Acquired with a Topcon TRC-50DX · central posterior field: 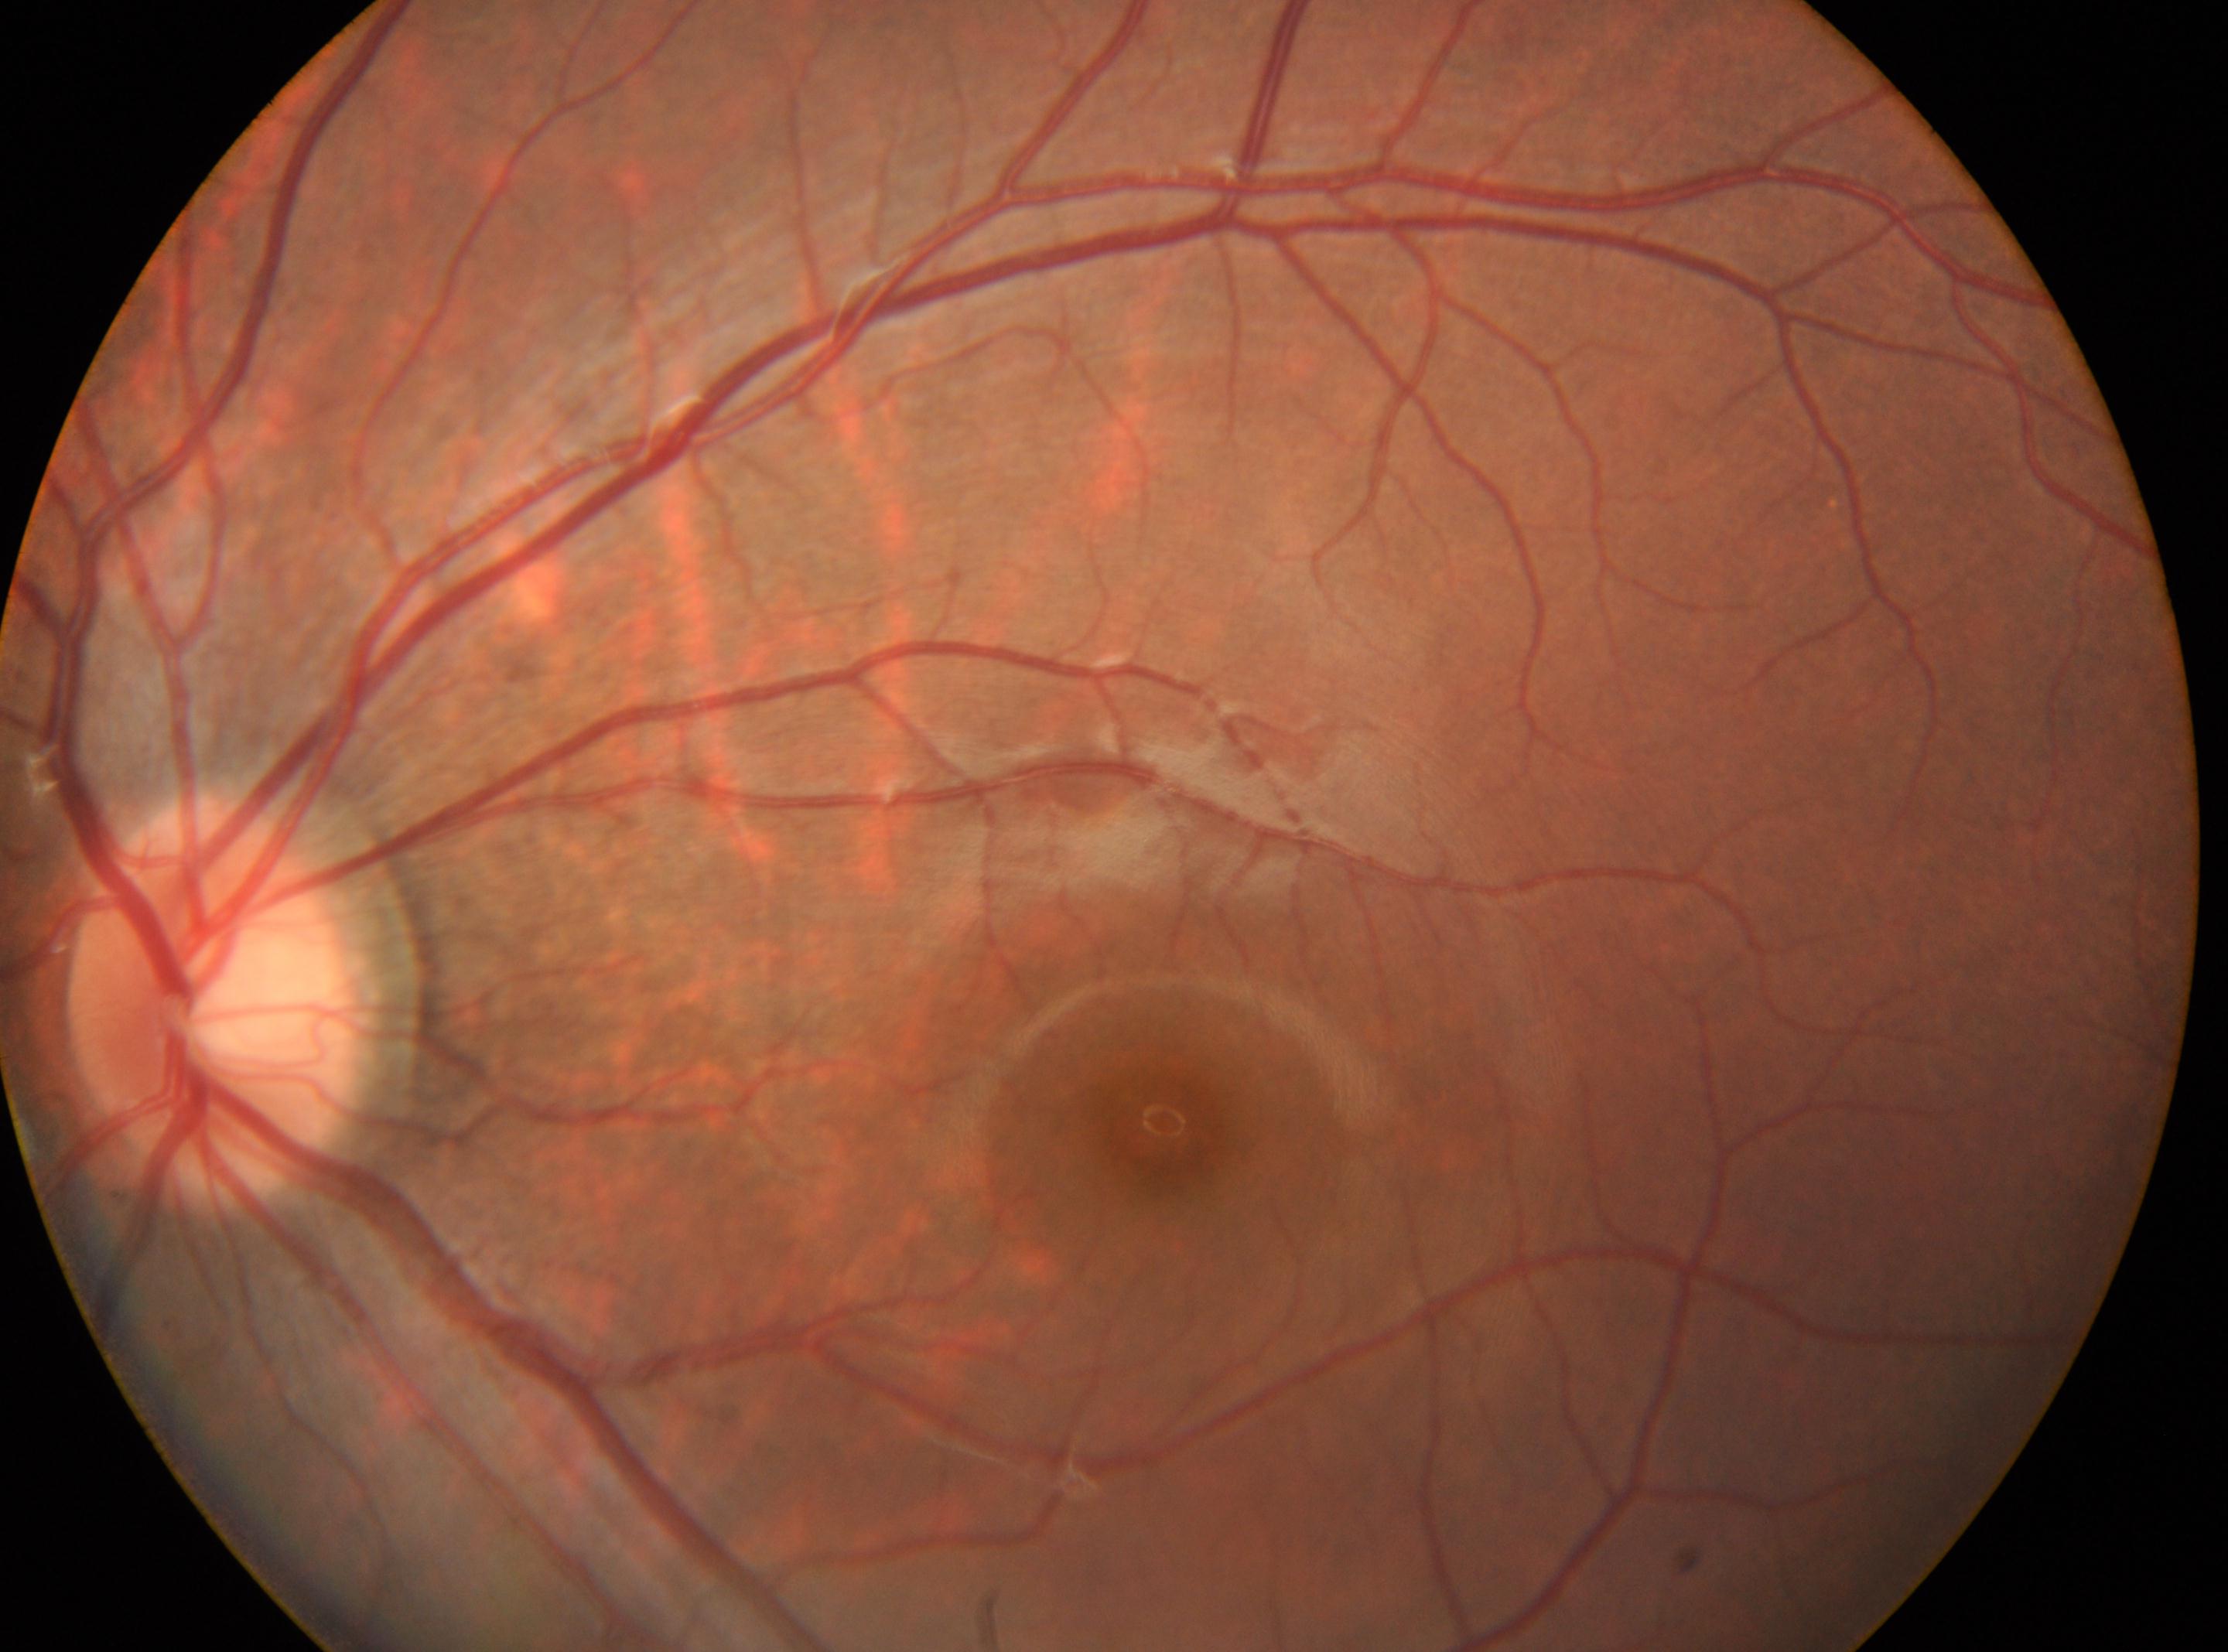

The optic disk is at (212, 998).
Diabetic retinopathy (DR) is 0/4.
This is the left eye.
Fovea located at (1162, 1121).